2361x1568 · centered on the macula.
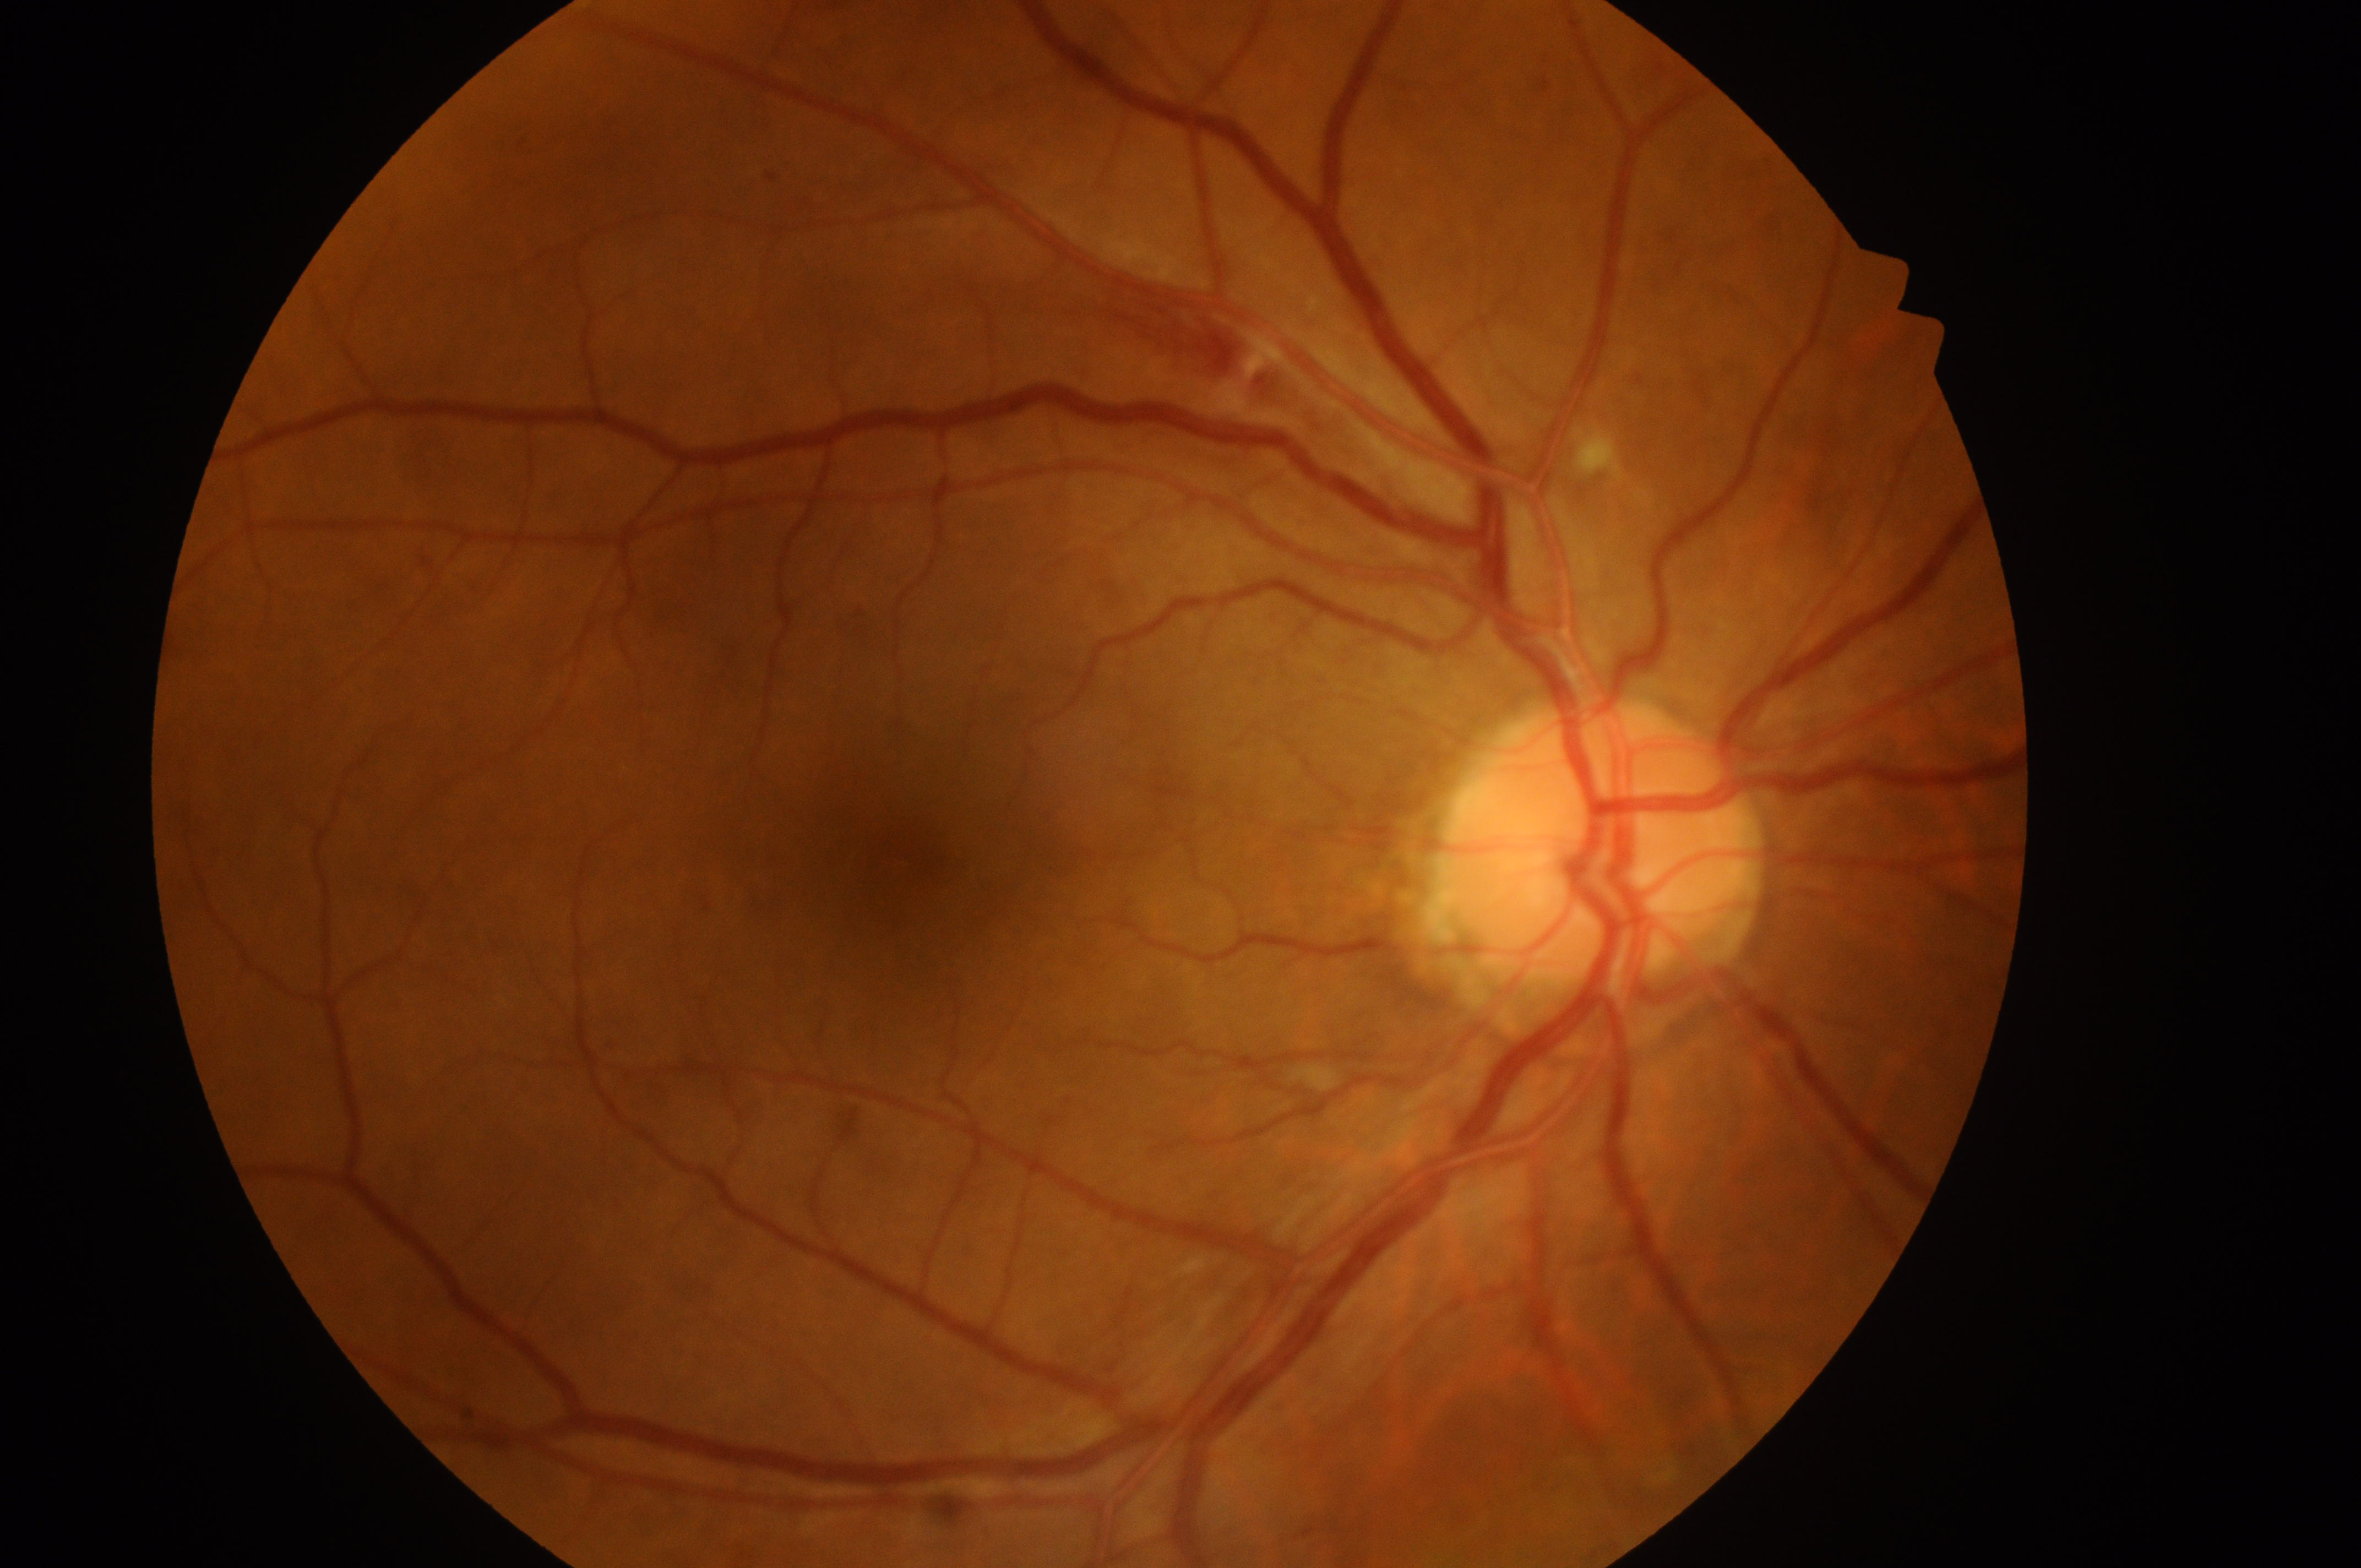 Q: Right or left eye?
A: OD
Q: Macular edema risk?
A: grade 0 (no risk) — no apparent hard exudates
Q: What is the DR grade?
A: moderate NPDR (2) — more than just microaneurysms but less than severe NPDR
Q: Locate the optic disc.
A: (x: 1598, y: 864)
Q: Fovea center?
A: (x: 916, y: 870)